1240x1240; pediatric retinal photograph (wide-field): 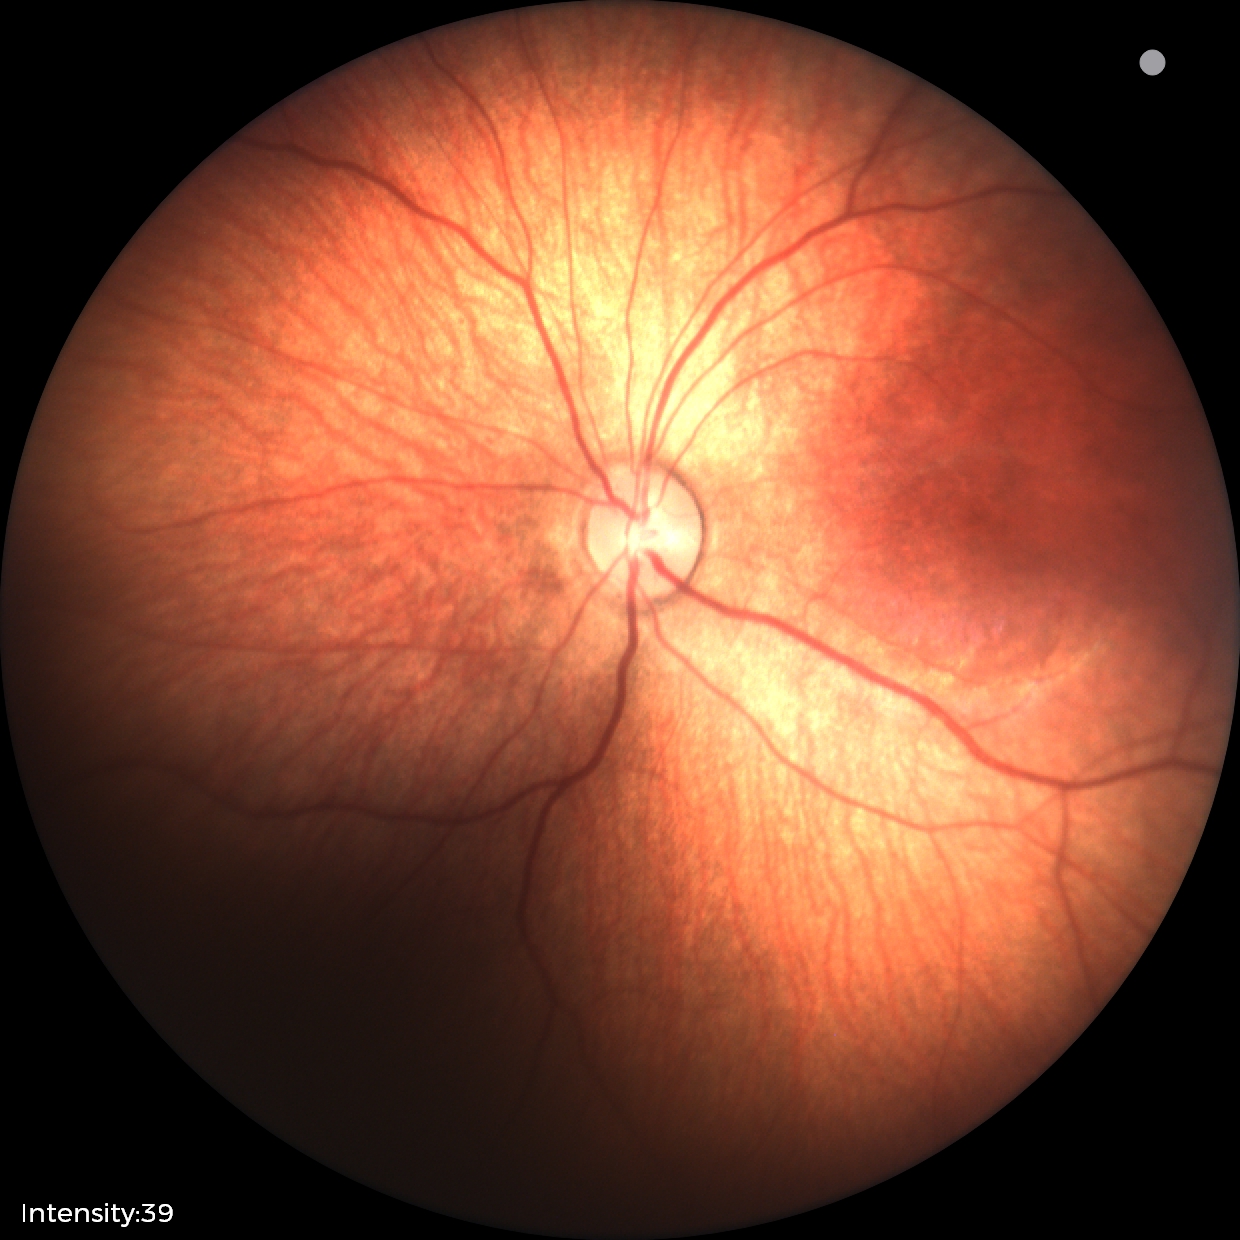

Screening examination with no abnormal retinal findings.